848x848. Nonmydriatic — 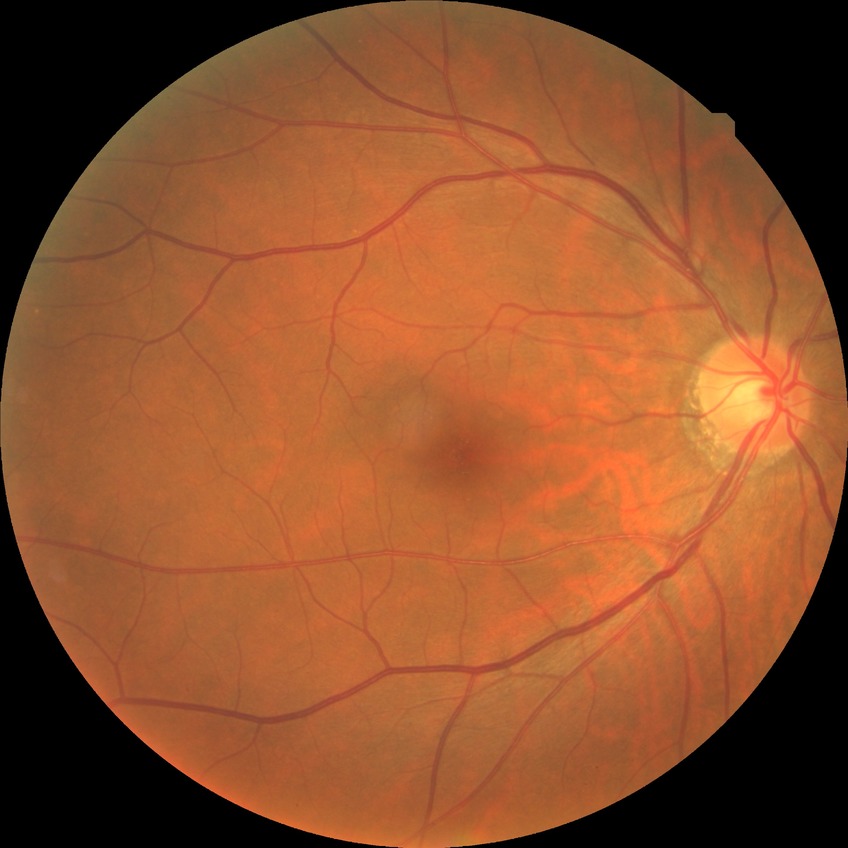   davis_grade: no diabetic retinopathy (NDR)